Davis DR grading:
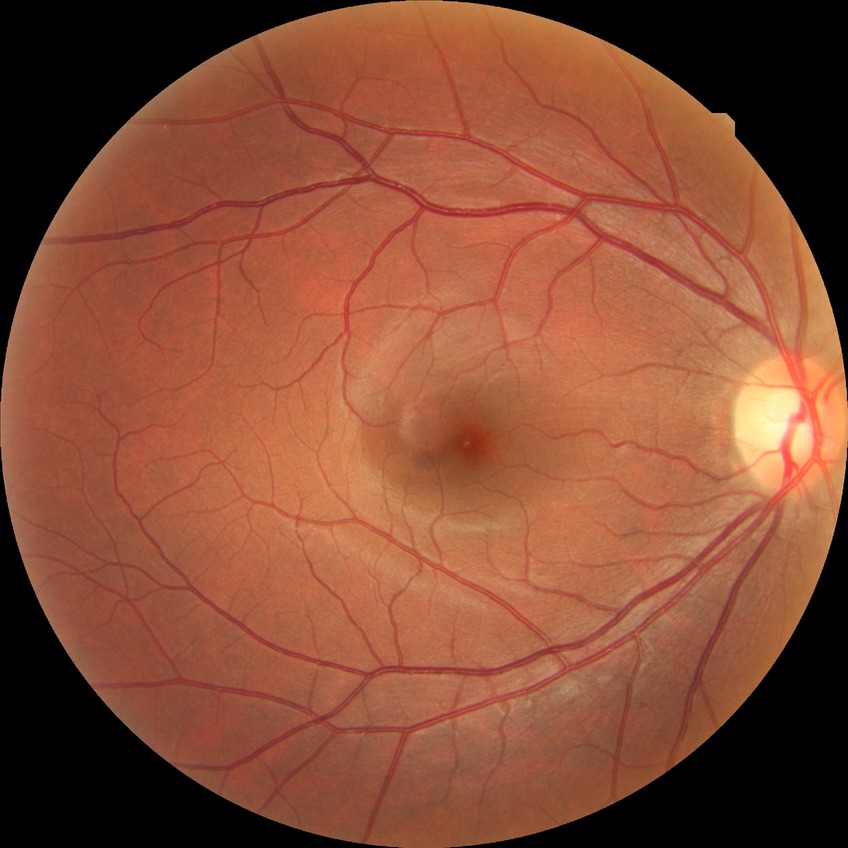
  davis_grade: no diabetic retinopathy